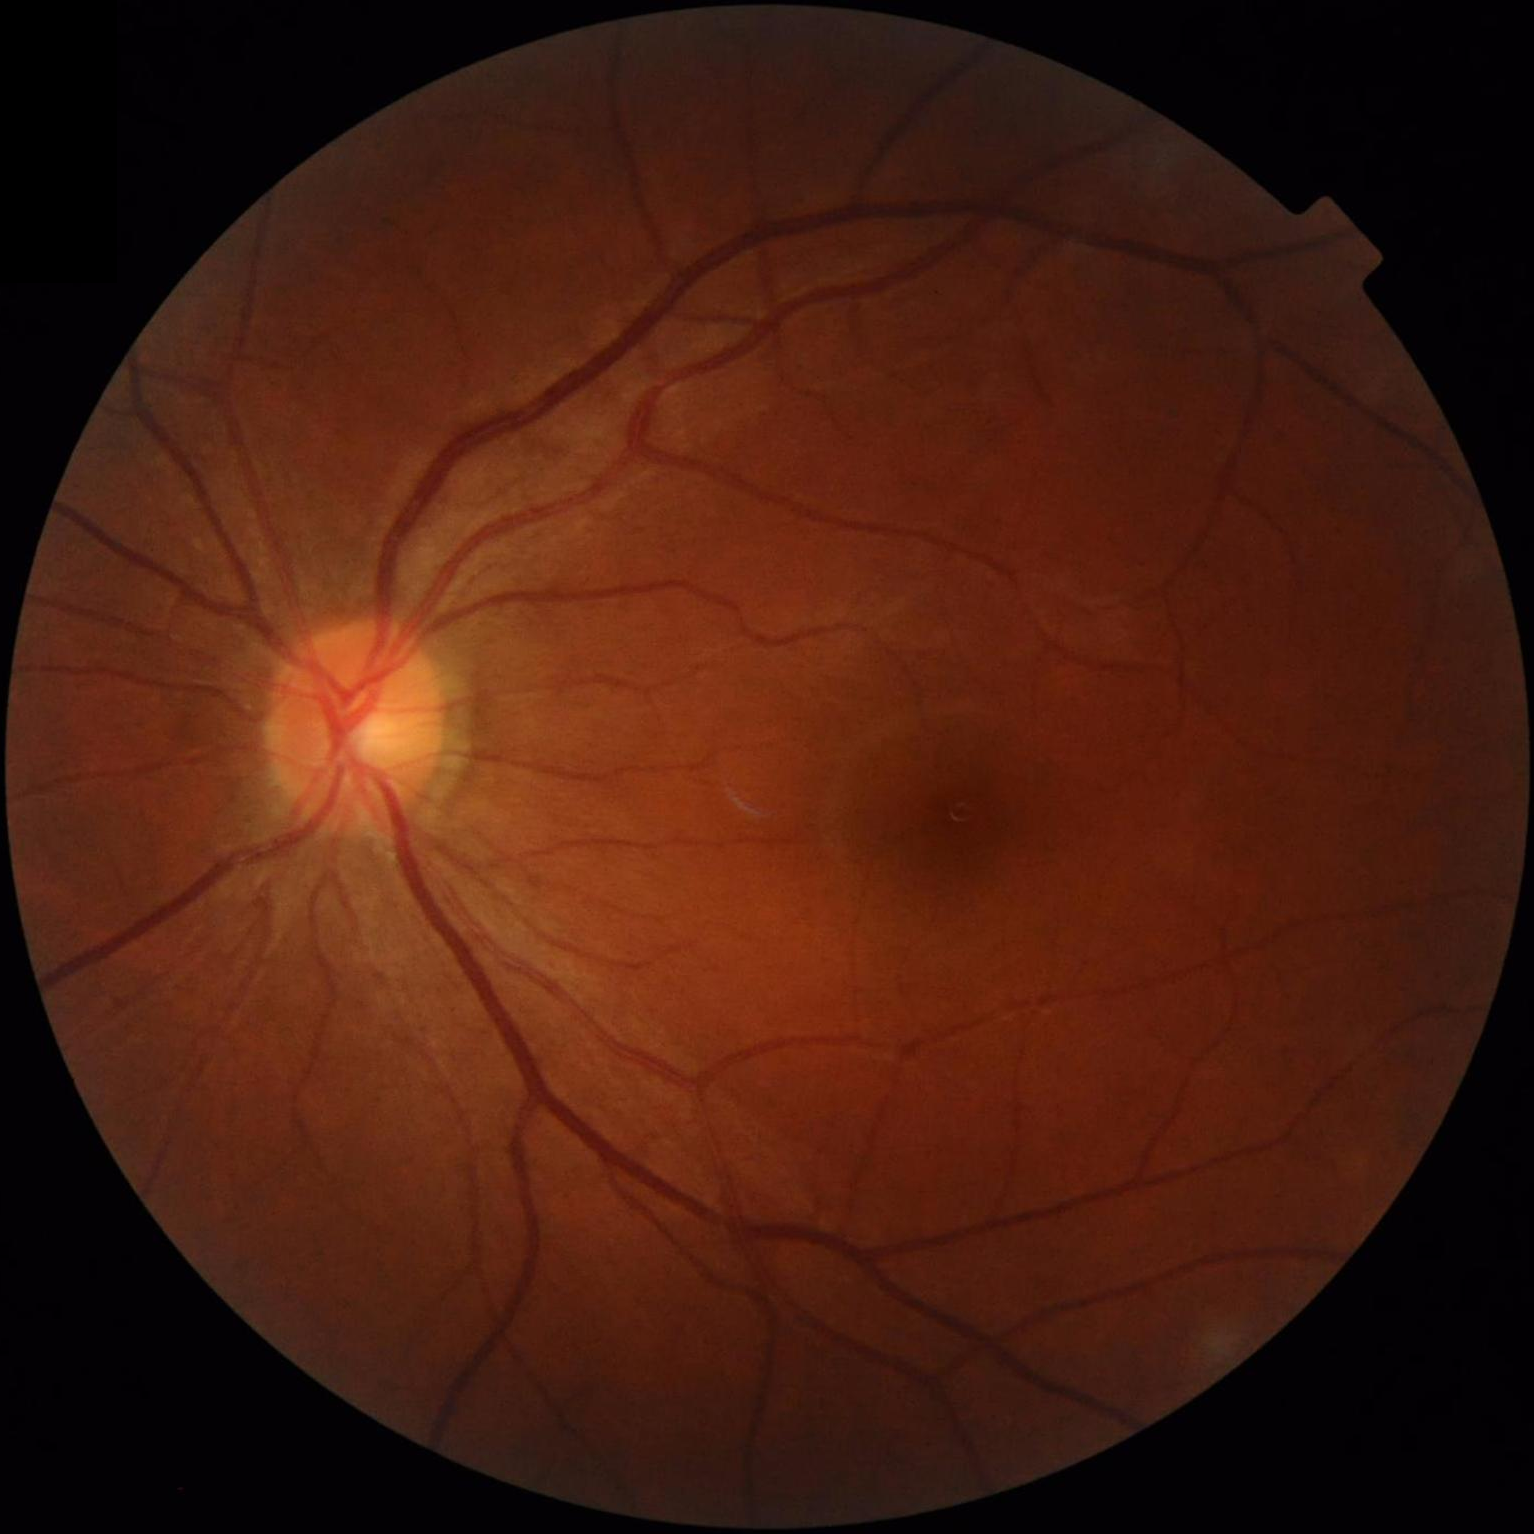
Acceptable image quality. No over- or under-exposure. Contrast is good.